Nonmydriatic fundus photograph. Image size 848x848 — 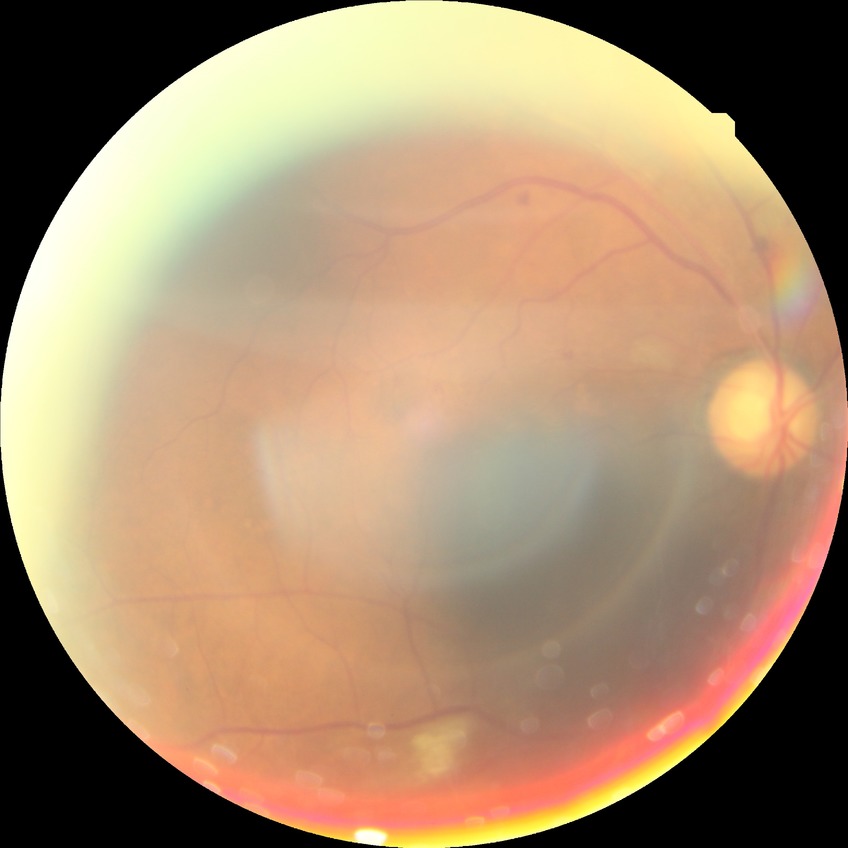
Diabetic retinopathy (DR) is PPDR (pre-proliferative diabetic retinopathy).